Diabetic retinopathy graded by the modified Davis classification; no pharmacologic dilation:
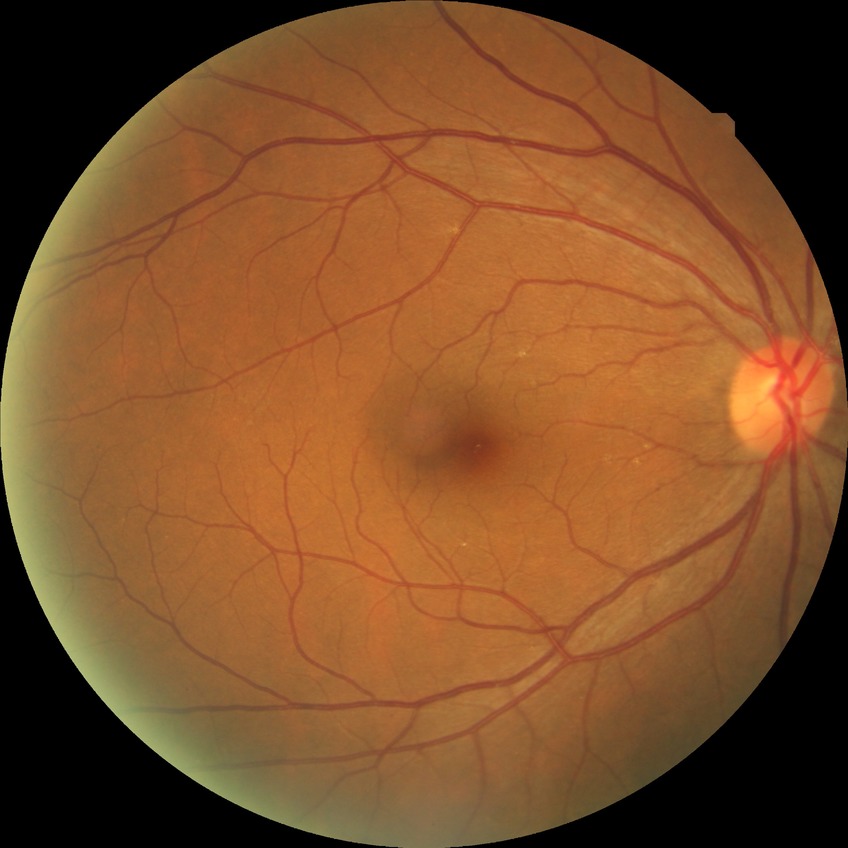

  davis_grade: no diabetic retinopathy (NDR)